Fundus photo:
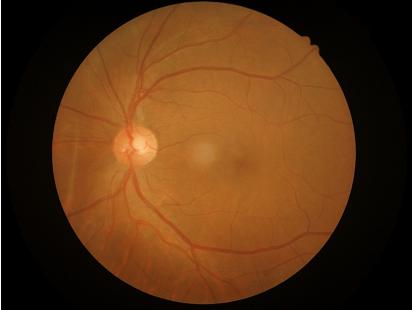
Optic disc, vessels, and background are in focus.
Overall quality is good and the image is gradable.
Contrast is good.
Illumination and color balance are good.